NIDEK AFC-230 · 848x848px — 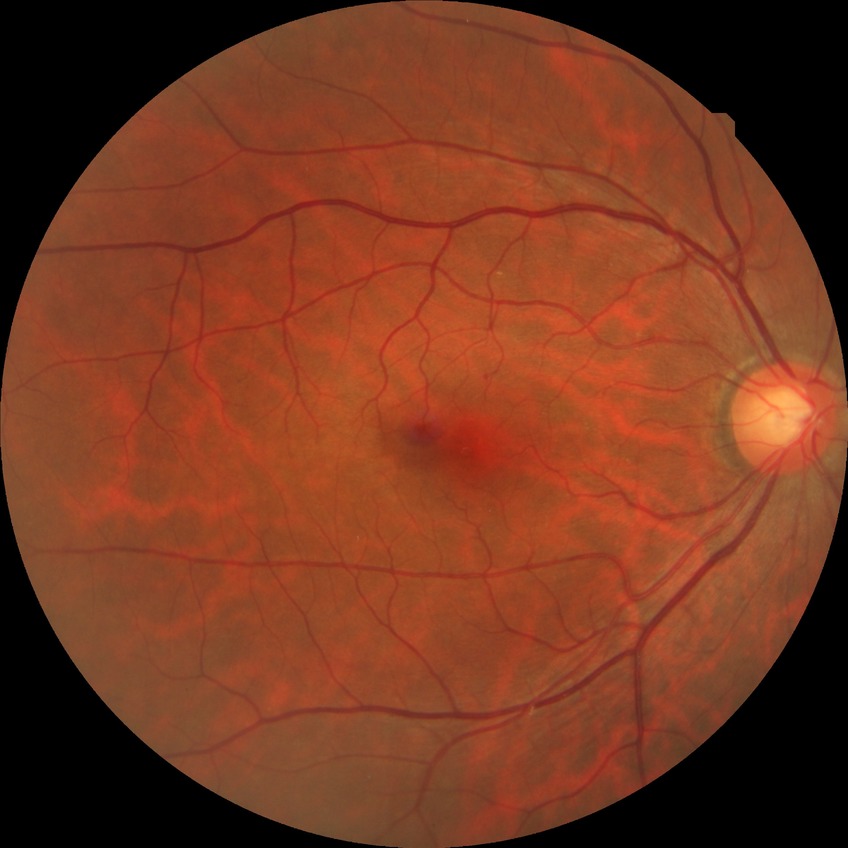

Diabetic retinopathy (DR) is no diabetic retinopathy (NDR).